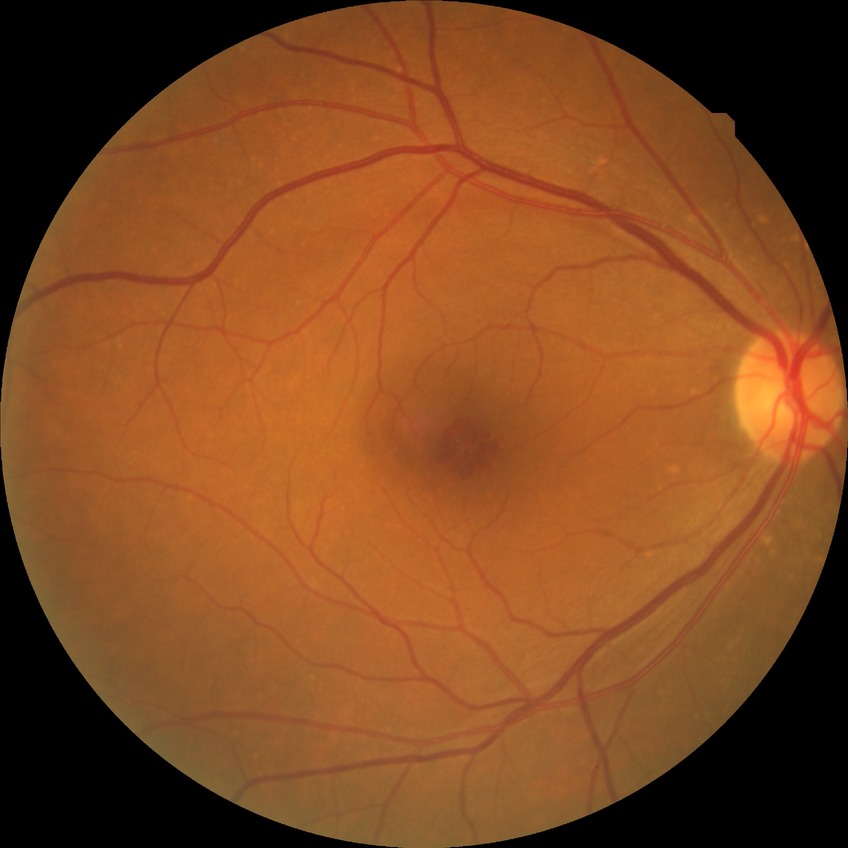

Diabetic retinopathy severity: no diabetic retinopathy.